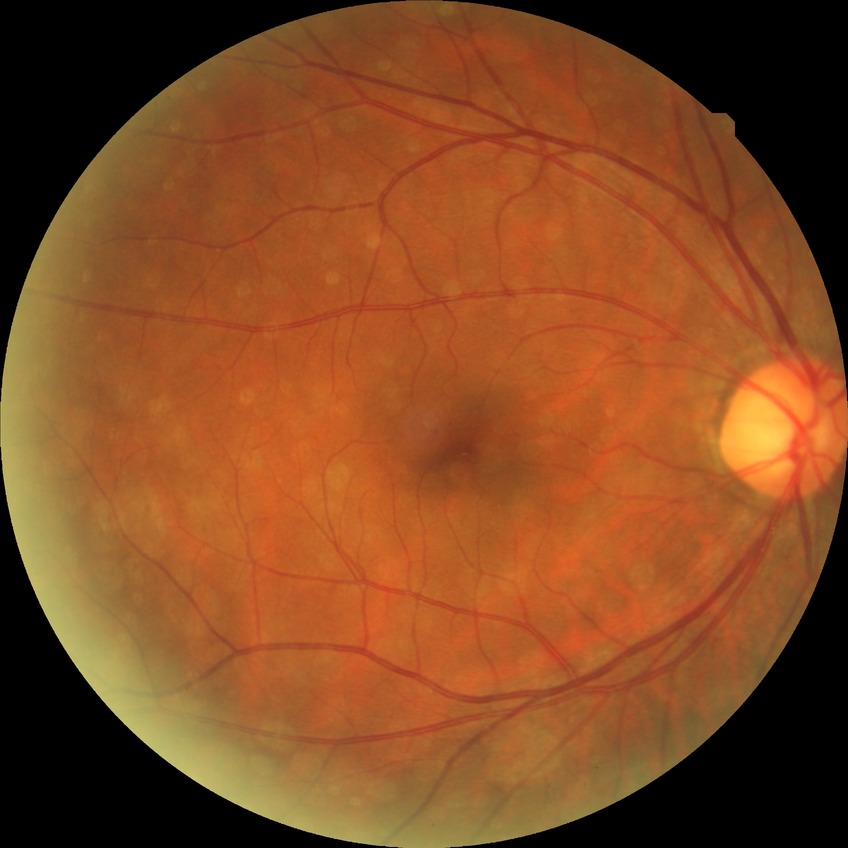 diabetic retinopathy (DR)=simple diabetic retinopathy (SDR).